Image size 848x848; 45 degree fundus photograph:
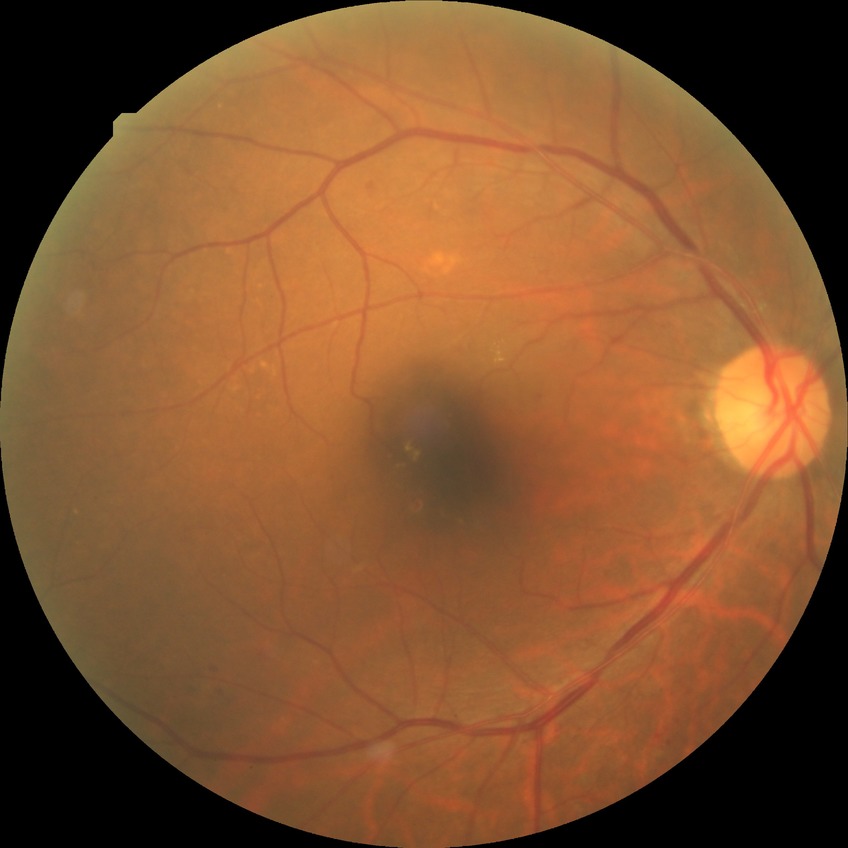 Disease class: non-proliferative diabetic retinopathy. Modified Davis grade is SDR.